FOV: 30 degrees; Topcon TRC-NW400; CFP; refractive error: -8 -1.25 x 46; non-mydriatic acquisition; centered on the optic disc; woman patient — 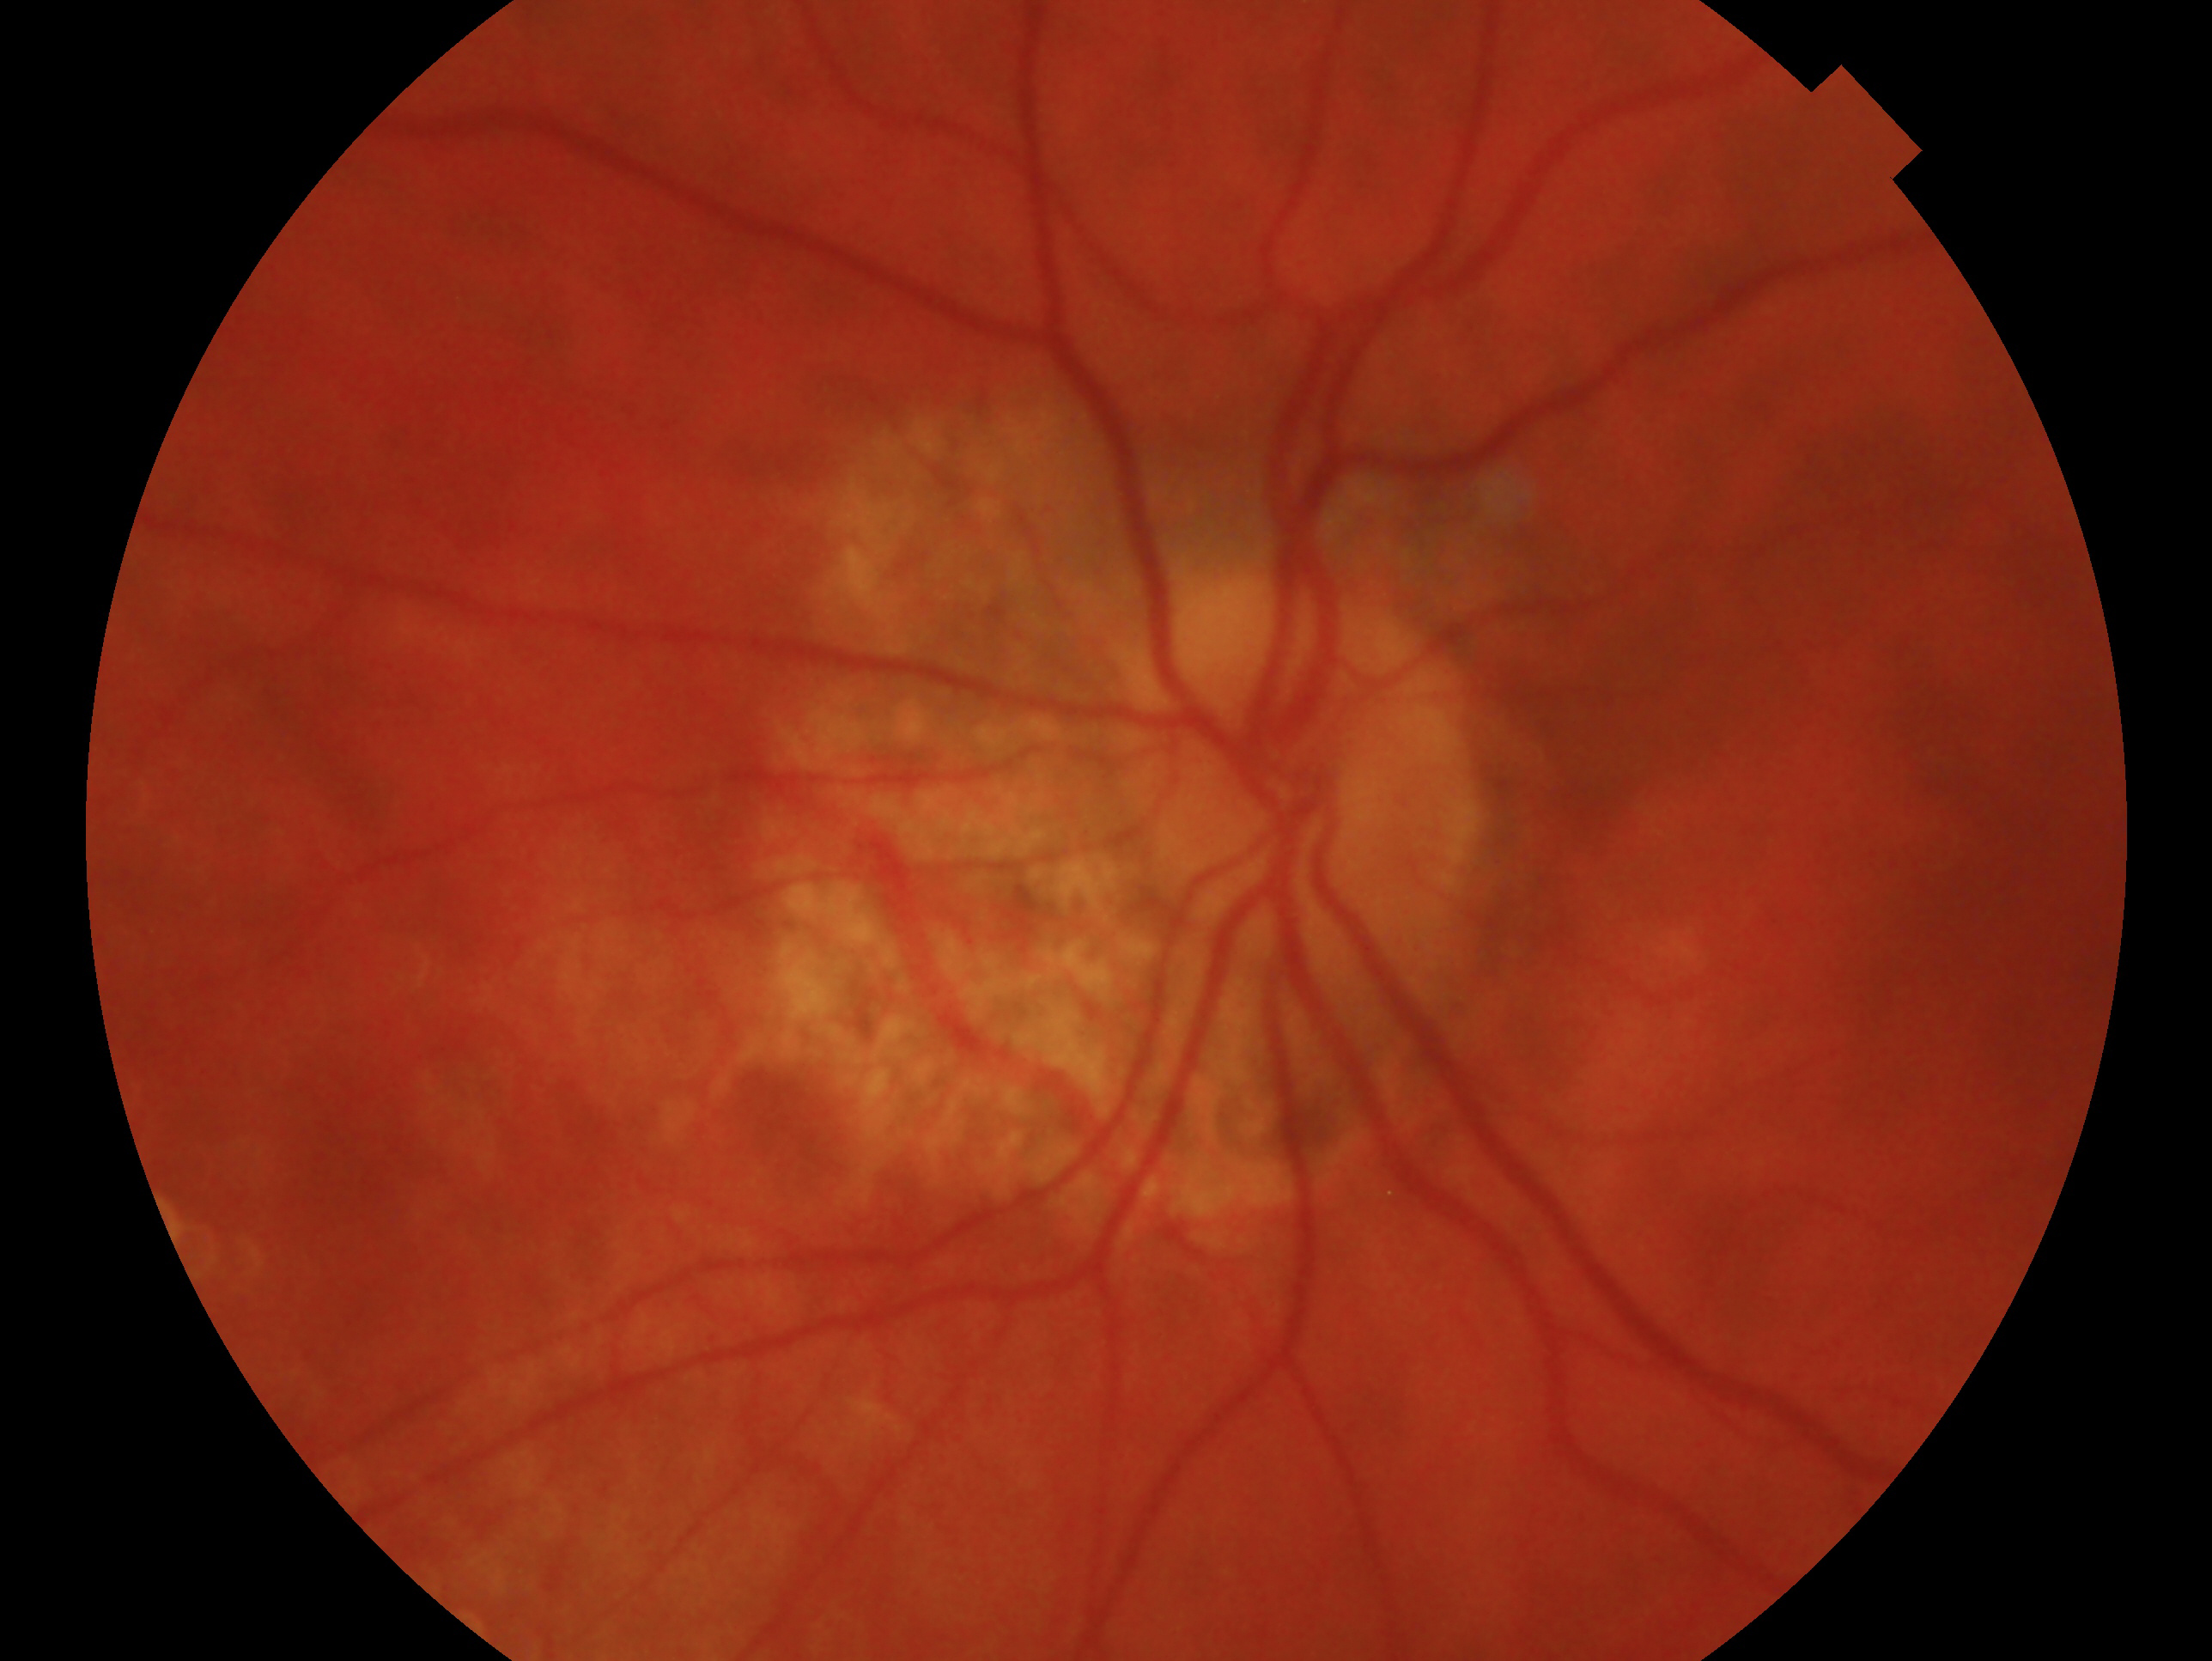 Q: Glaucoma assessment?
A: consistent with glaucoma — clinically confirmed glaucoma with characteristic optic nerve damage
Q: Which eye is imaged?
A: OS